130° field of view (Clarity RetCam 3) · pediatric wide-field fundus photograph
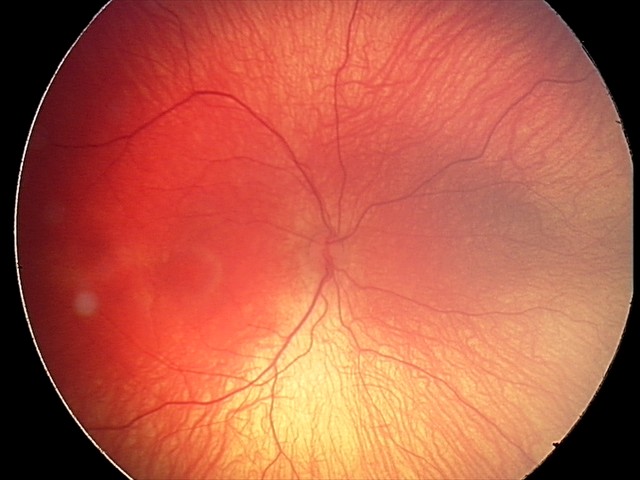 From an examination with diagnosis of retinopathy of prematurity stage 1 — demarcation line between vascular and avascular retina.
Plus disease absent.